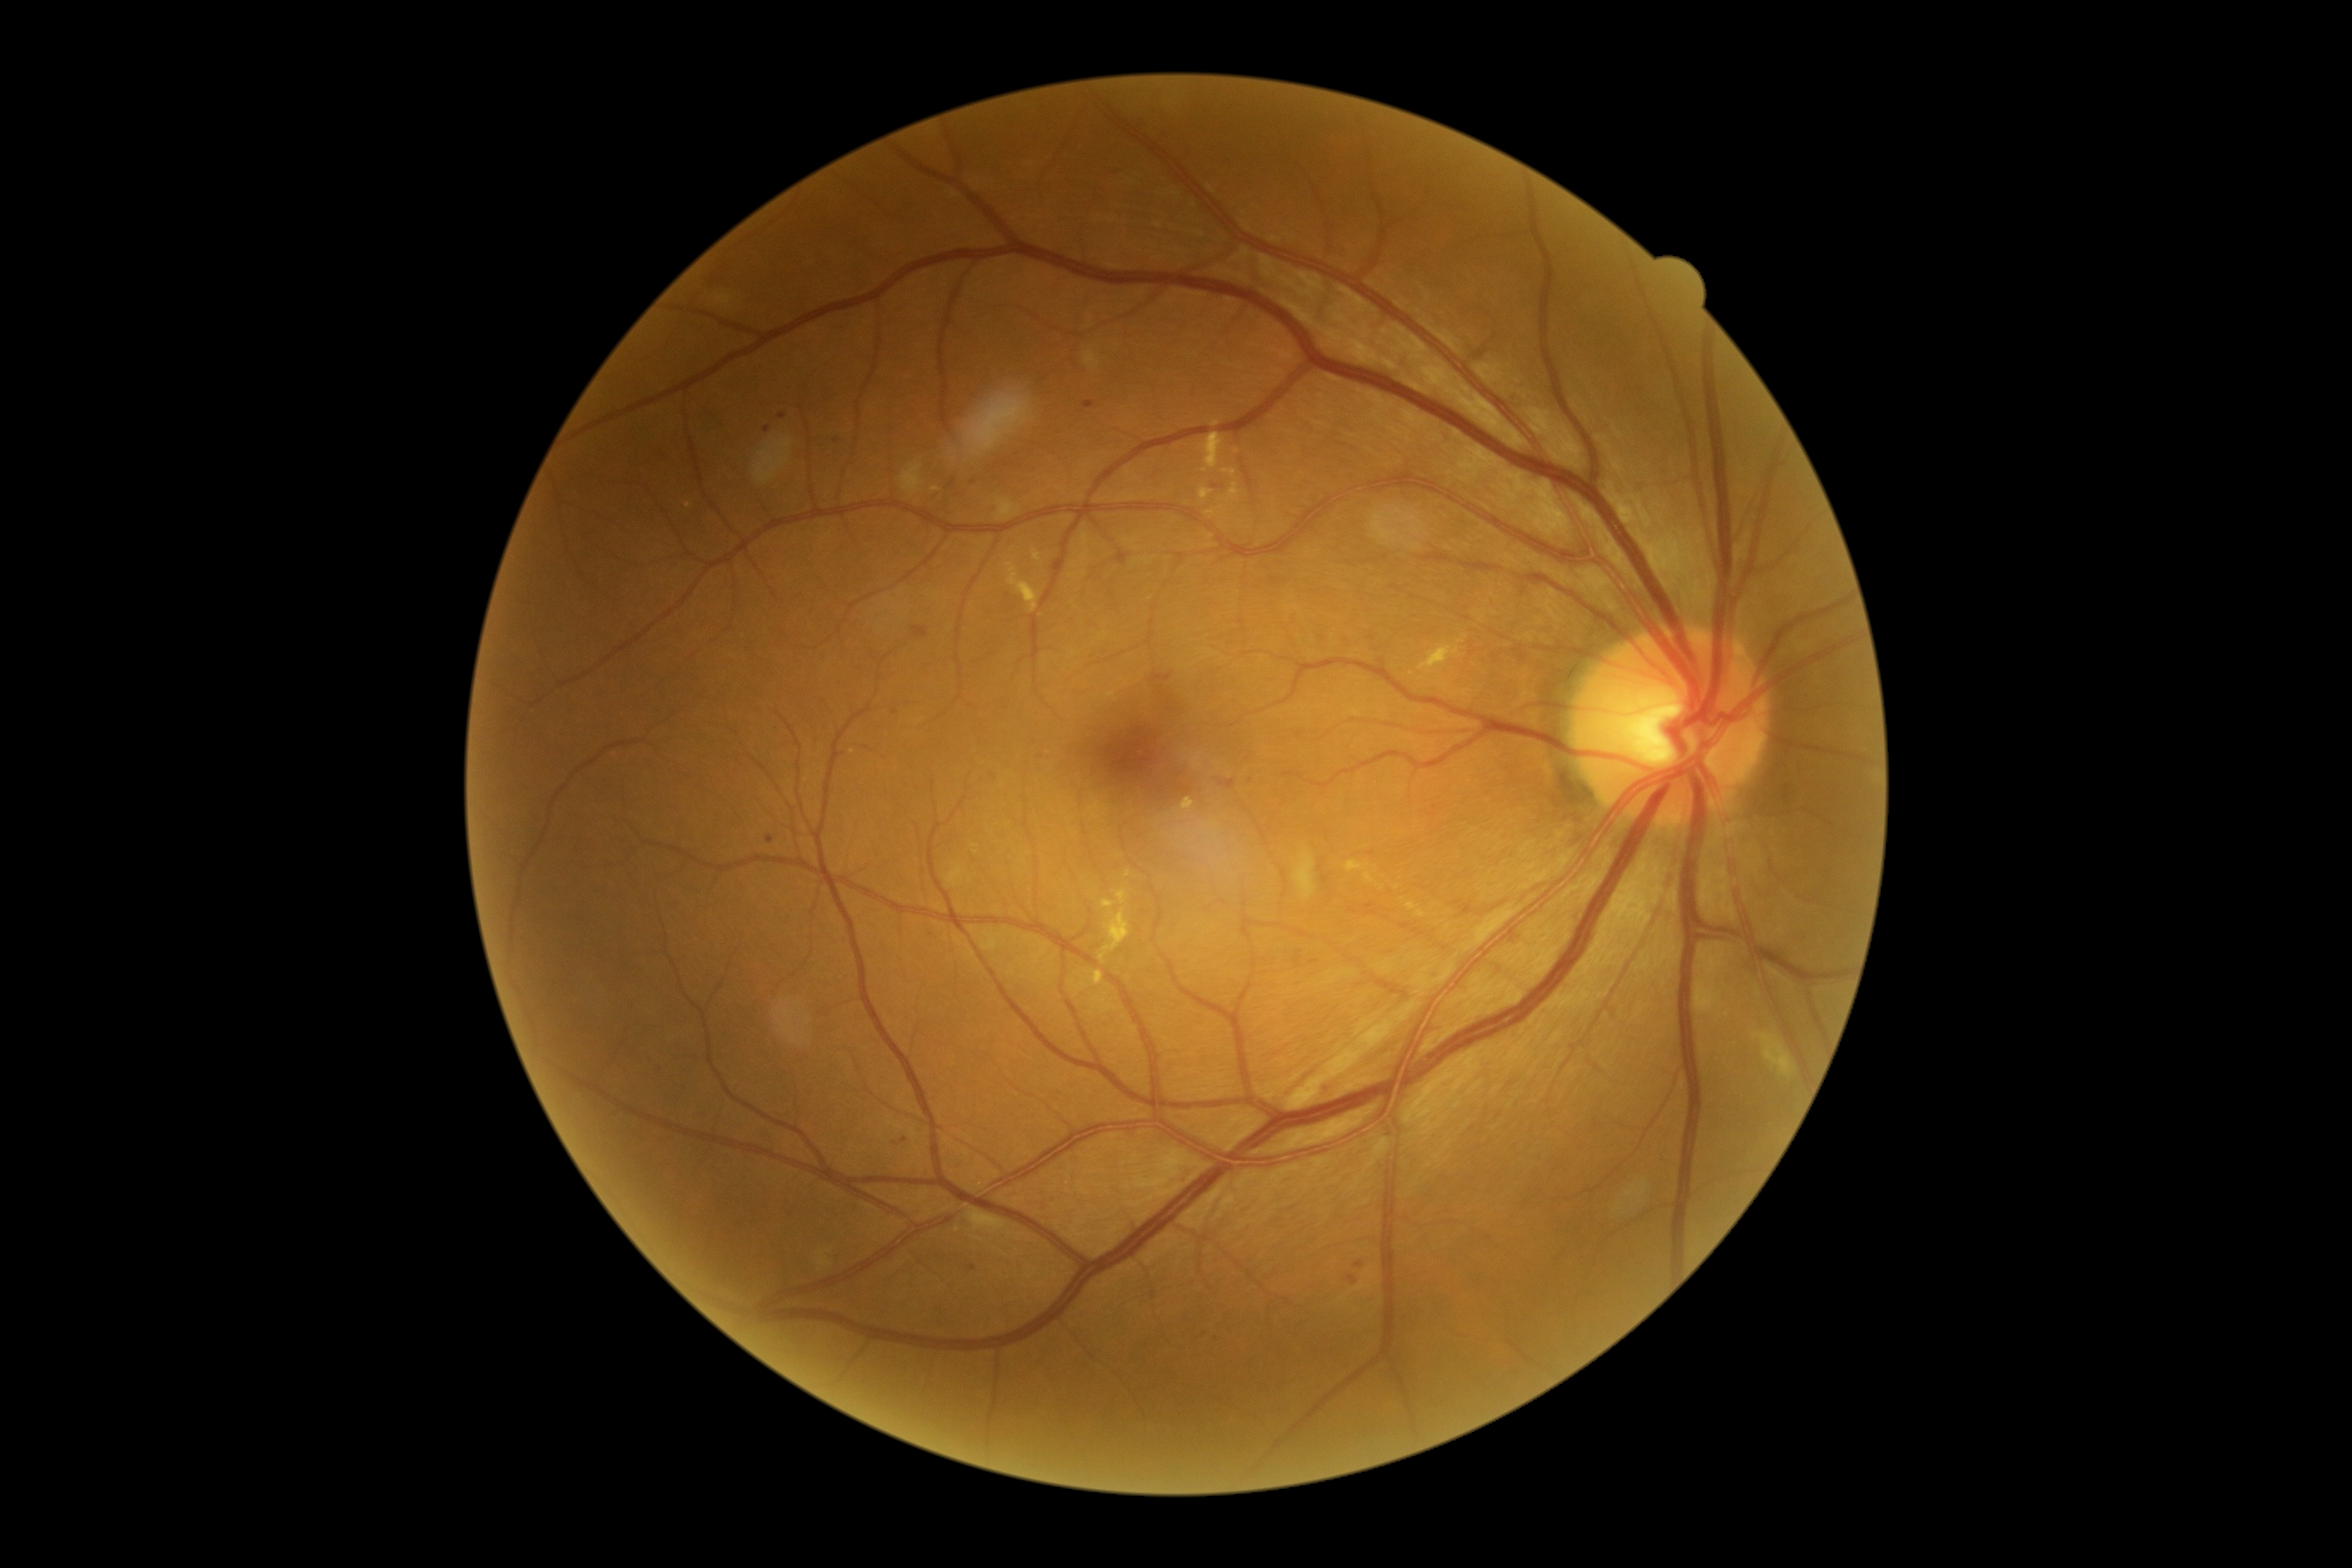 Diabetic retinopathy (DR): moderate non-proliferative diabetic retinopathy (grade 2)
Selected lesions:
hemorrhages (HEs): none
microaneurysms (MAs) (partial): (1349, 1277, 1357, 1285); (766, 836, 775, 843); (1151, 673, 1173, 683); (1220, 780, 1235, 790); (1366, 903, 1375, 910); (1399, 924, 1411, 931)
Small MAs approximately at <pt>895,713</pt>; <pt>993,776</pt>; <pt>1188,792</pt>; <pt>905,1140</pt>; <pt>1359,1265</pt>
hard exudates (EXs) (partial): (1352, 709, 1364, 716); (1099, 900, 1130, 965); (946, 862, 967, 888); (1345, 862, 1369, 873); (1222, 469, 1237, 477); (1091, 971, 1105, 986); (1206, 510, 1216, 518); (1419, 646, 1461, 673)
Small EXs approximately at <pt>936,491</pt>; <pt>688,506</pt>; <pt>853,752</pt>; <pt>1216,424</pt>
soft exudates (SEs): (814, 1249, 833, 1273); (1294, 850, 1316, 900); (1753, 1032, 1798, 1077); (969, 1210, 1007, 1234)